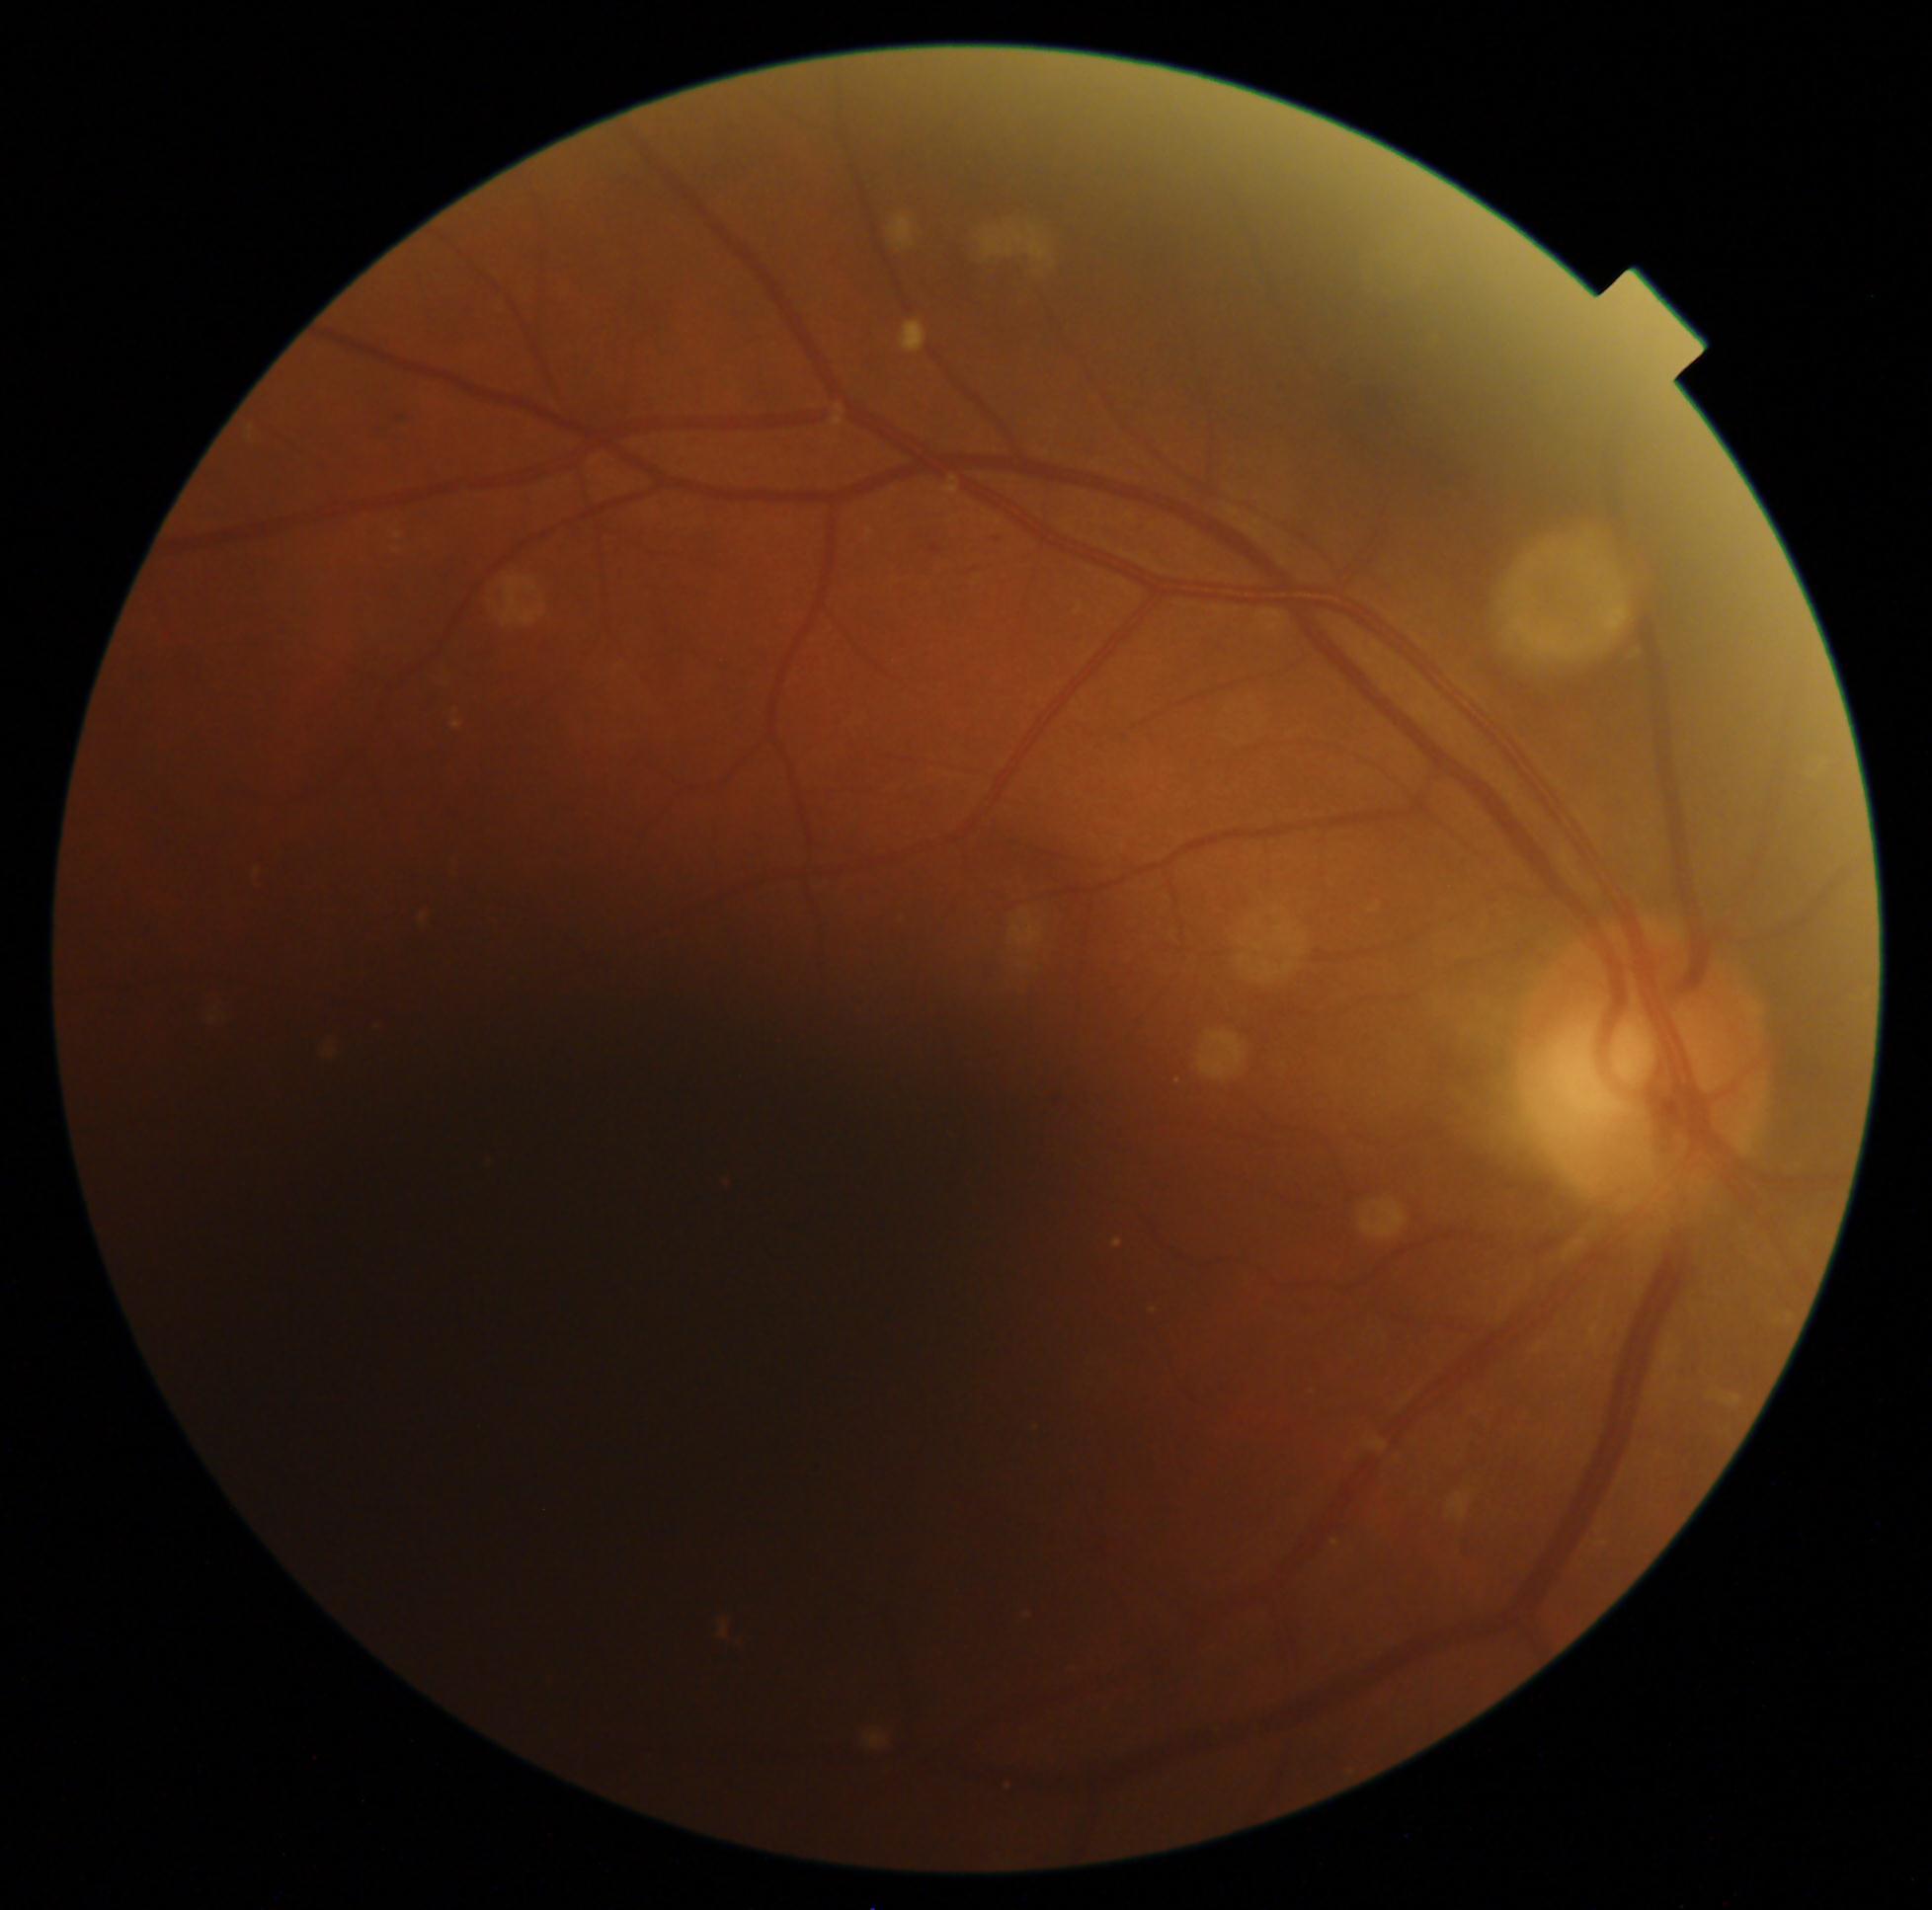
Diabetic retinopathy (DR) is grade 2 (moderate NPDR).